Wide-field contact fundus photograph of an infant. 1240 x 1240 pixels — 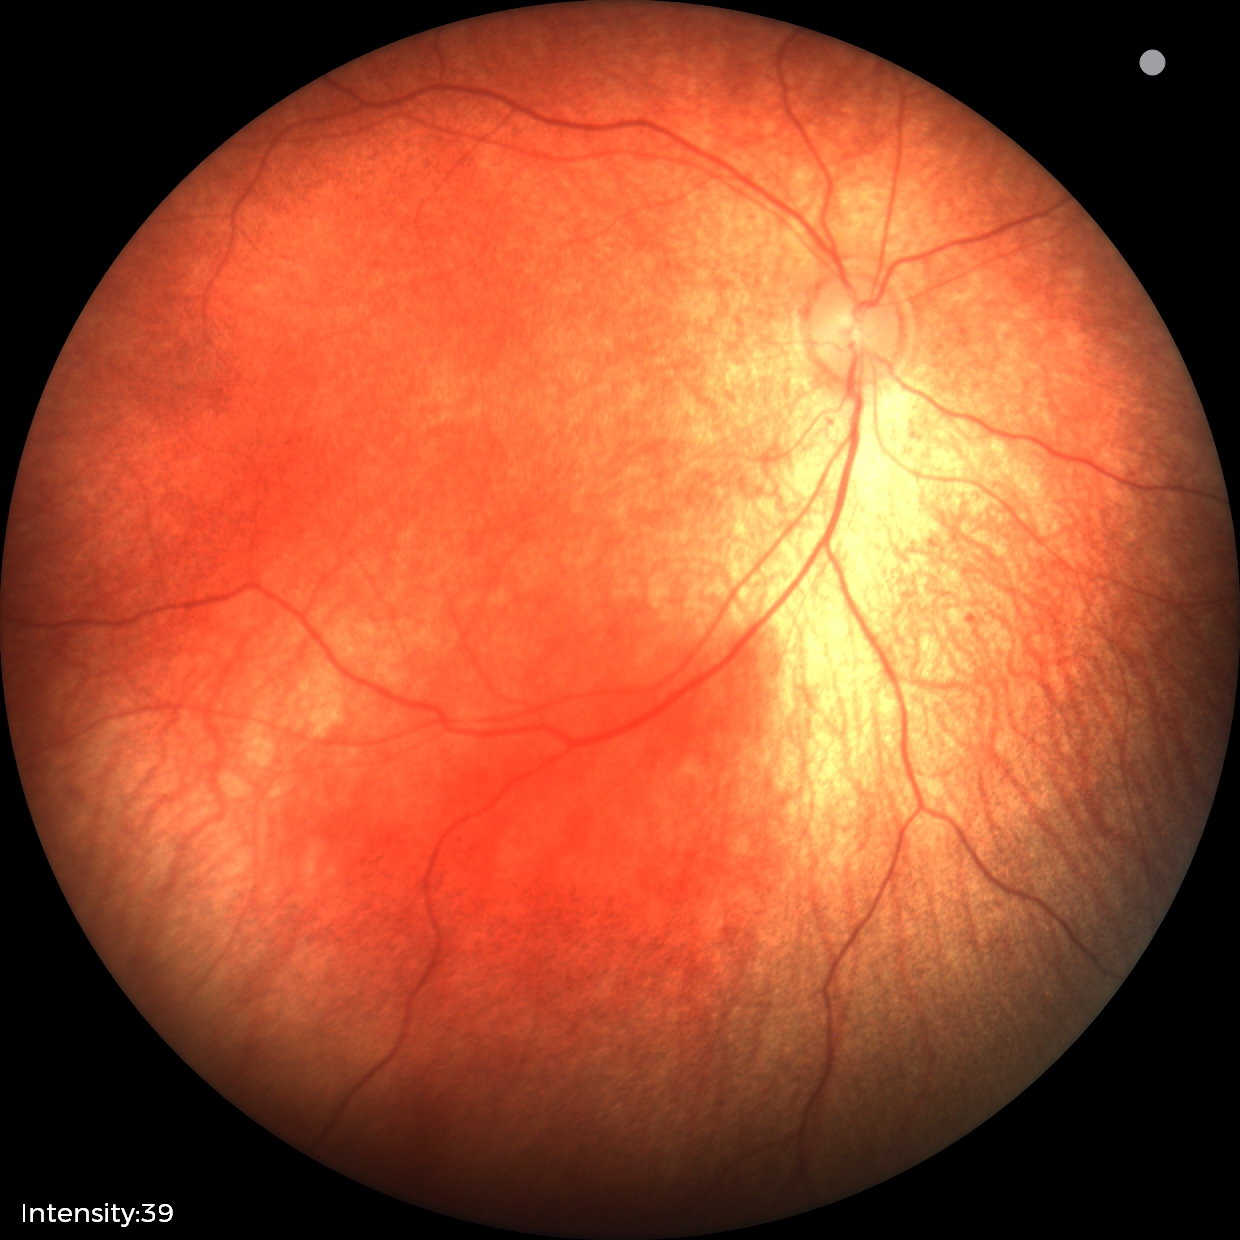
Normal screening examination.